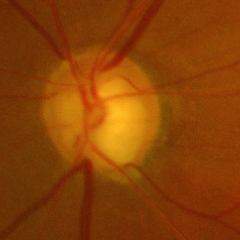 Fundus image with findings of advanced glaucoma. Defined as near-total cupping of the optic nerve head, with or without severe visual field loss within the central 10 degrees of fixation.